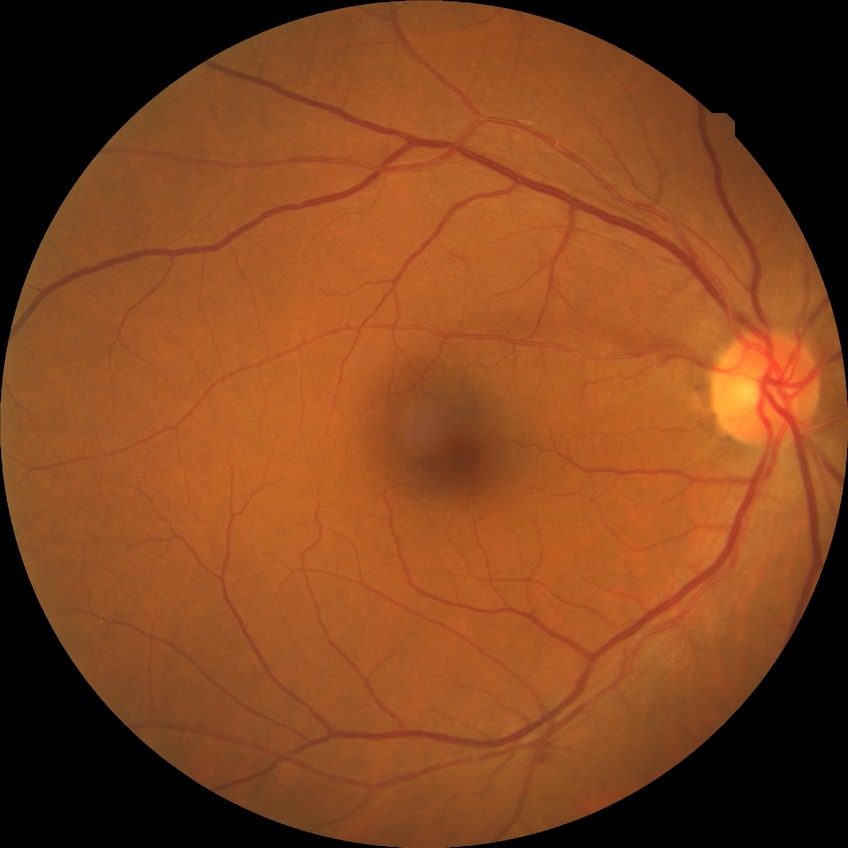

Diabetic retinopathy (DR) is NDR (no diabetic retinopathy).